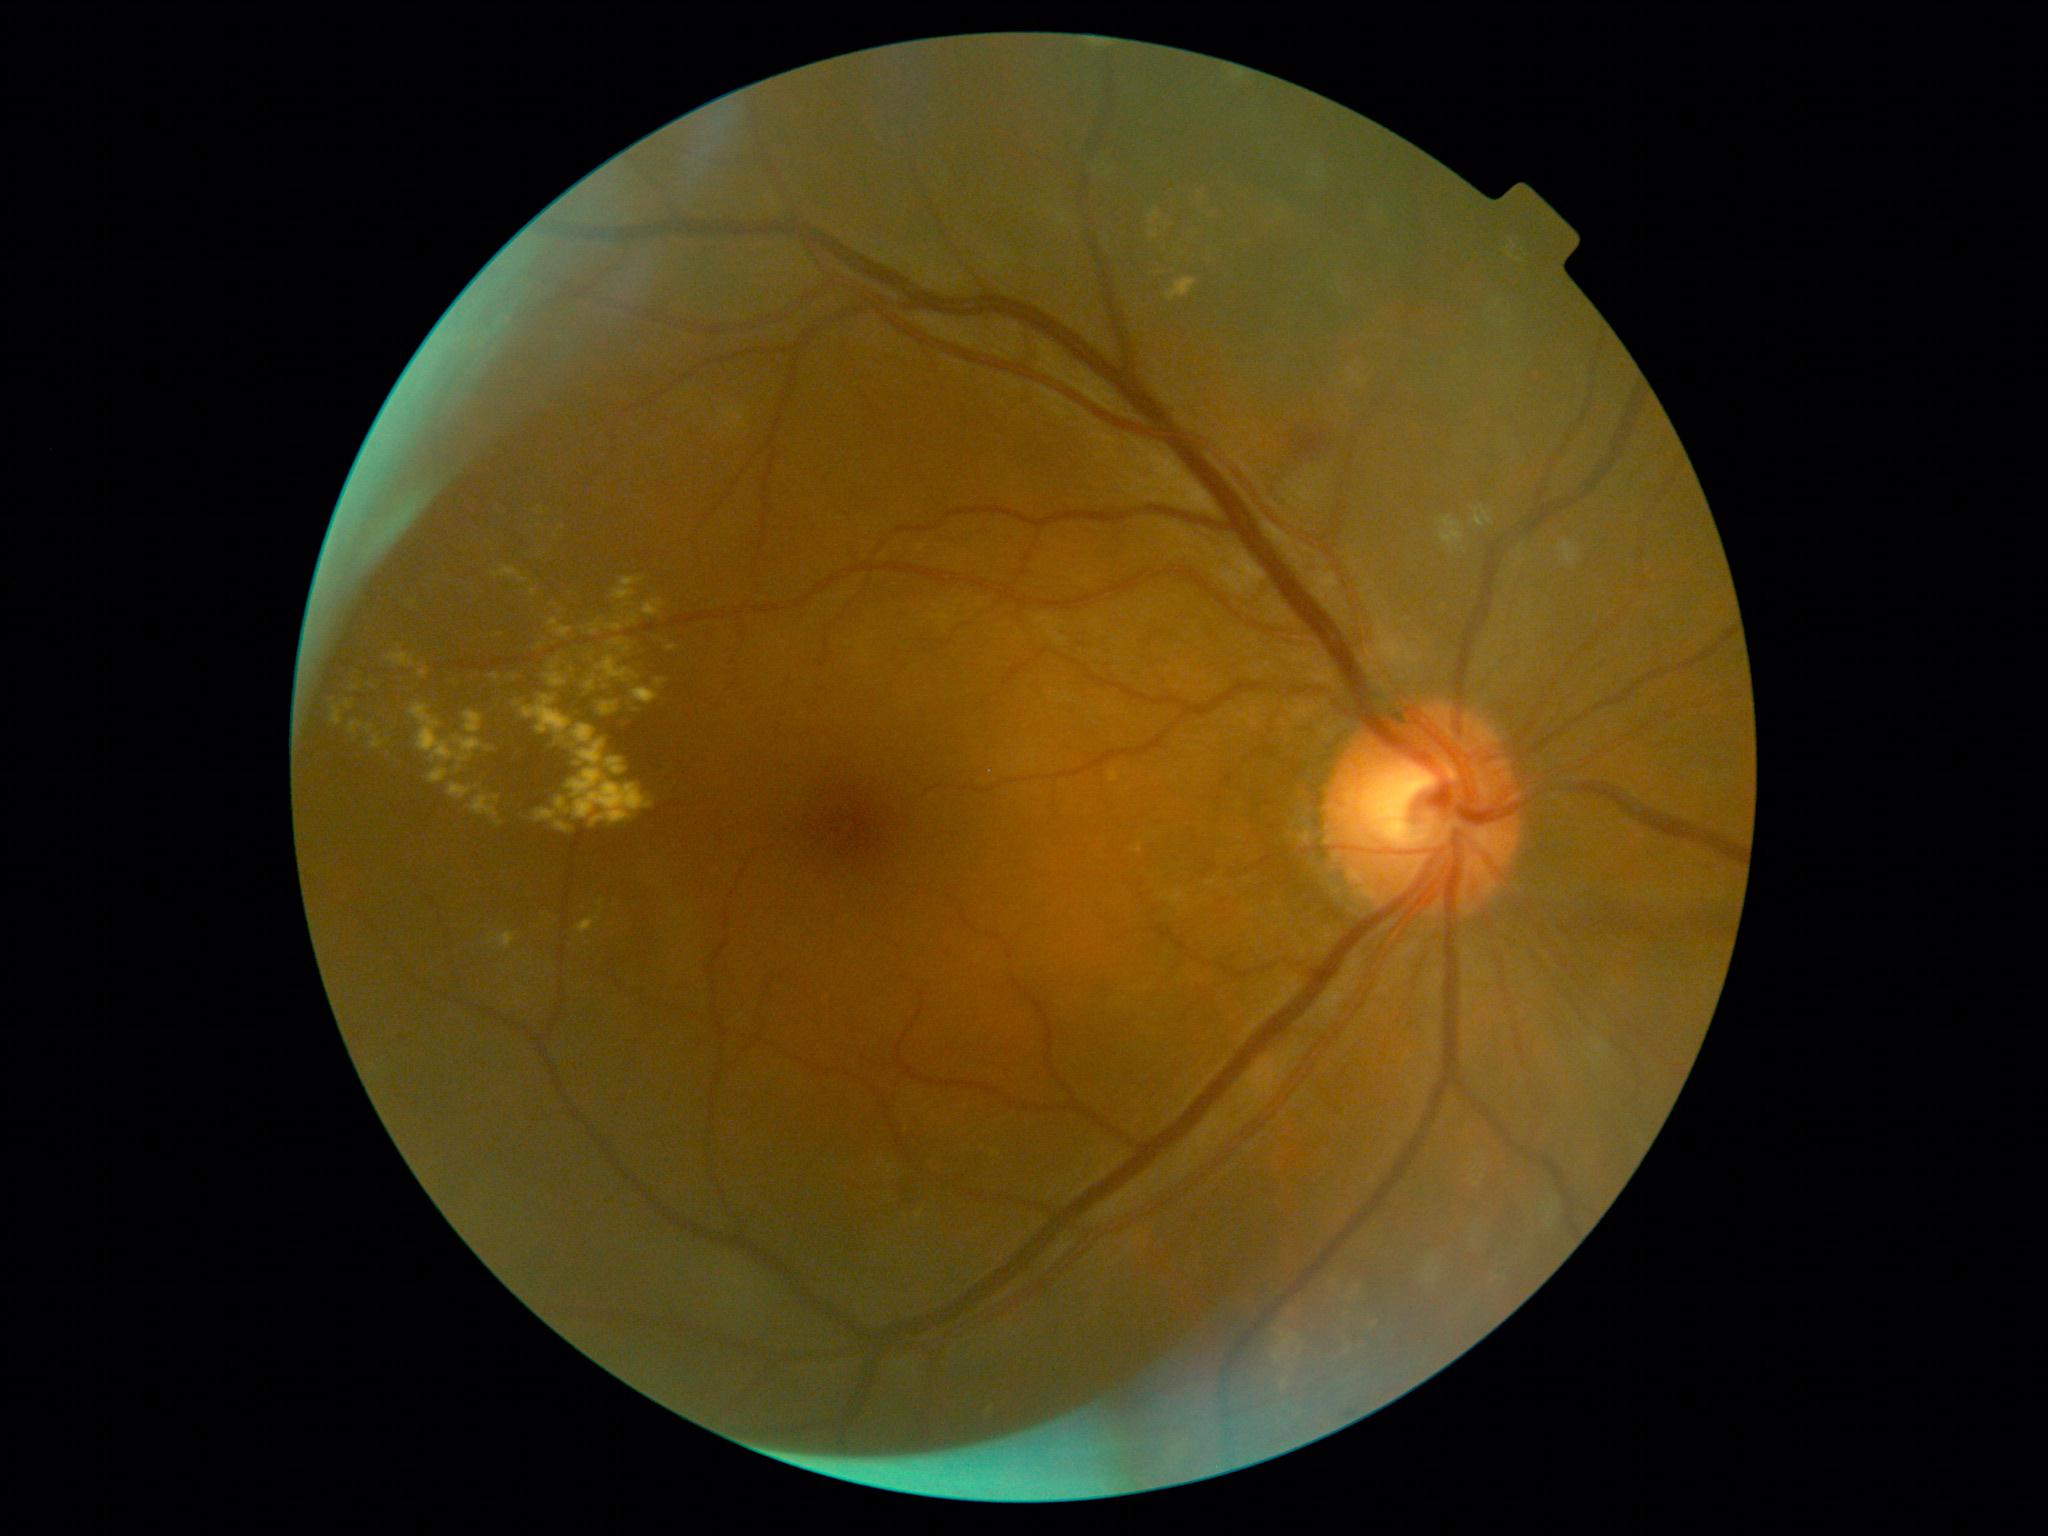
{"partial":true,"dr_grade":2,"dr_grade_name":"moderate NPDR","lesions":{"ex":[[614,577,644,600],[351,685,359,692],[667,645,680,652],[596,656,641,683],[1273,1329,1302,1364],[609,639,625,646],[576,916,601,935],[628,613,638,627],[915,1210,924,1219],[428,768,448,784],[349,722,364,734],[371,735,387,749],[549,619,572,637],[1341,1335,1366,1357]],"ex_small_approx":[[513,678],[606,687],[601,911]]}}